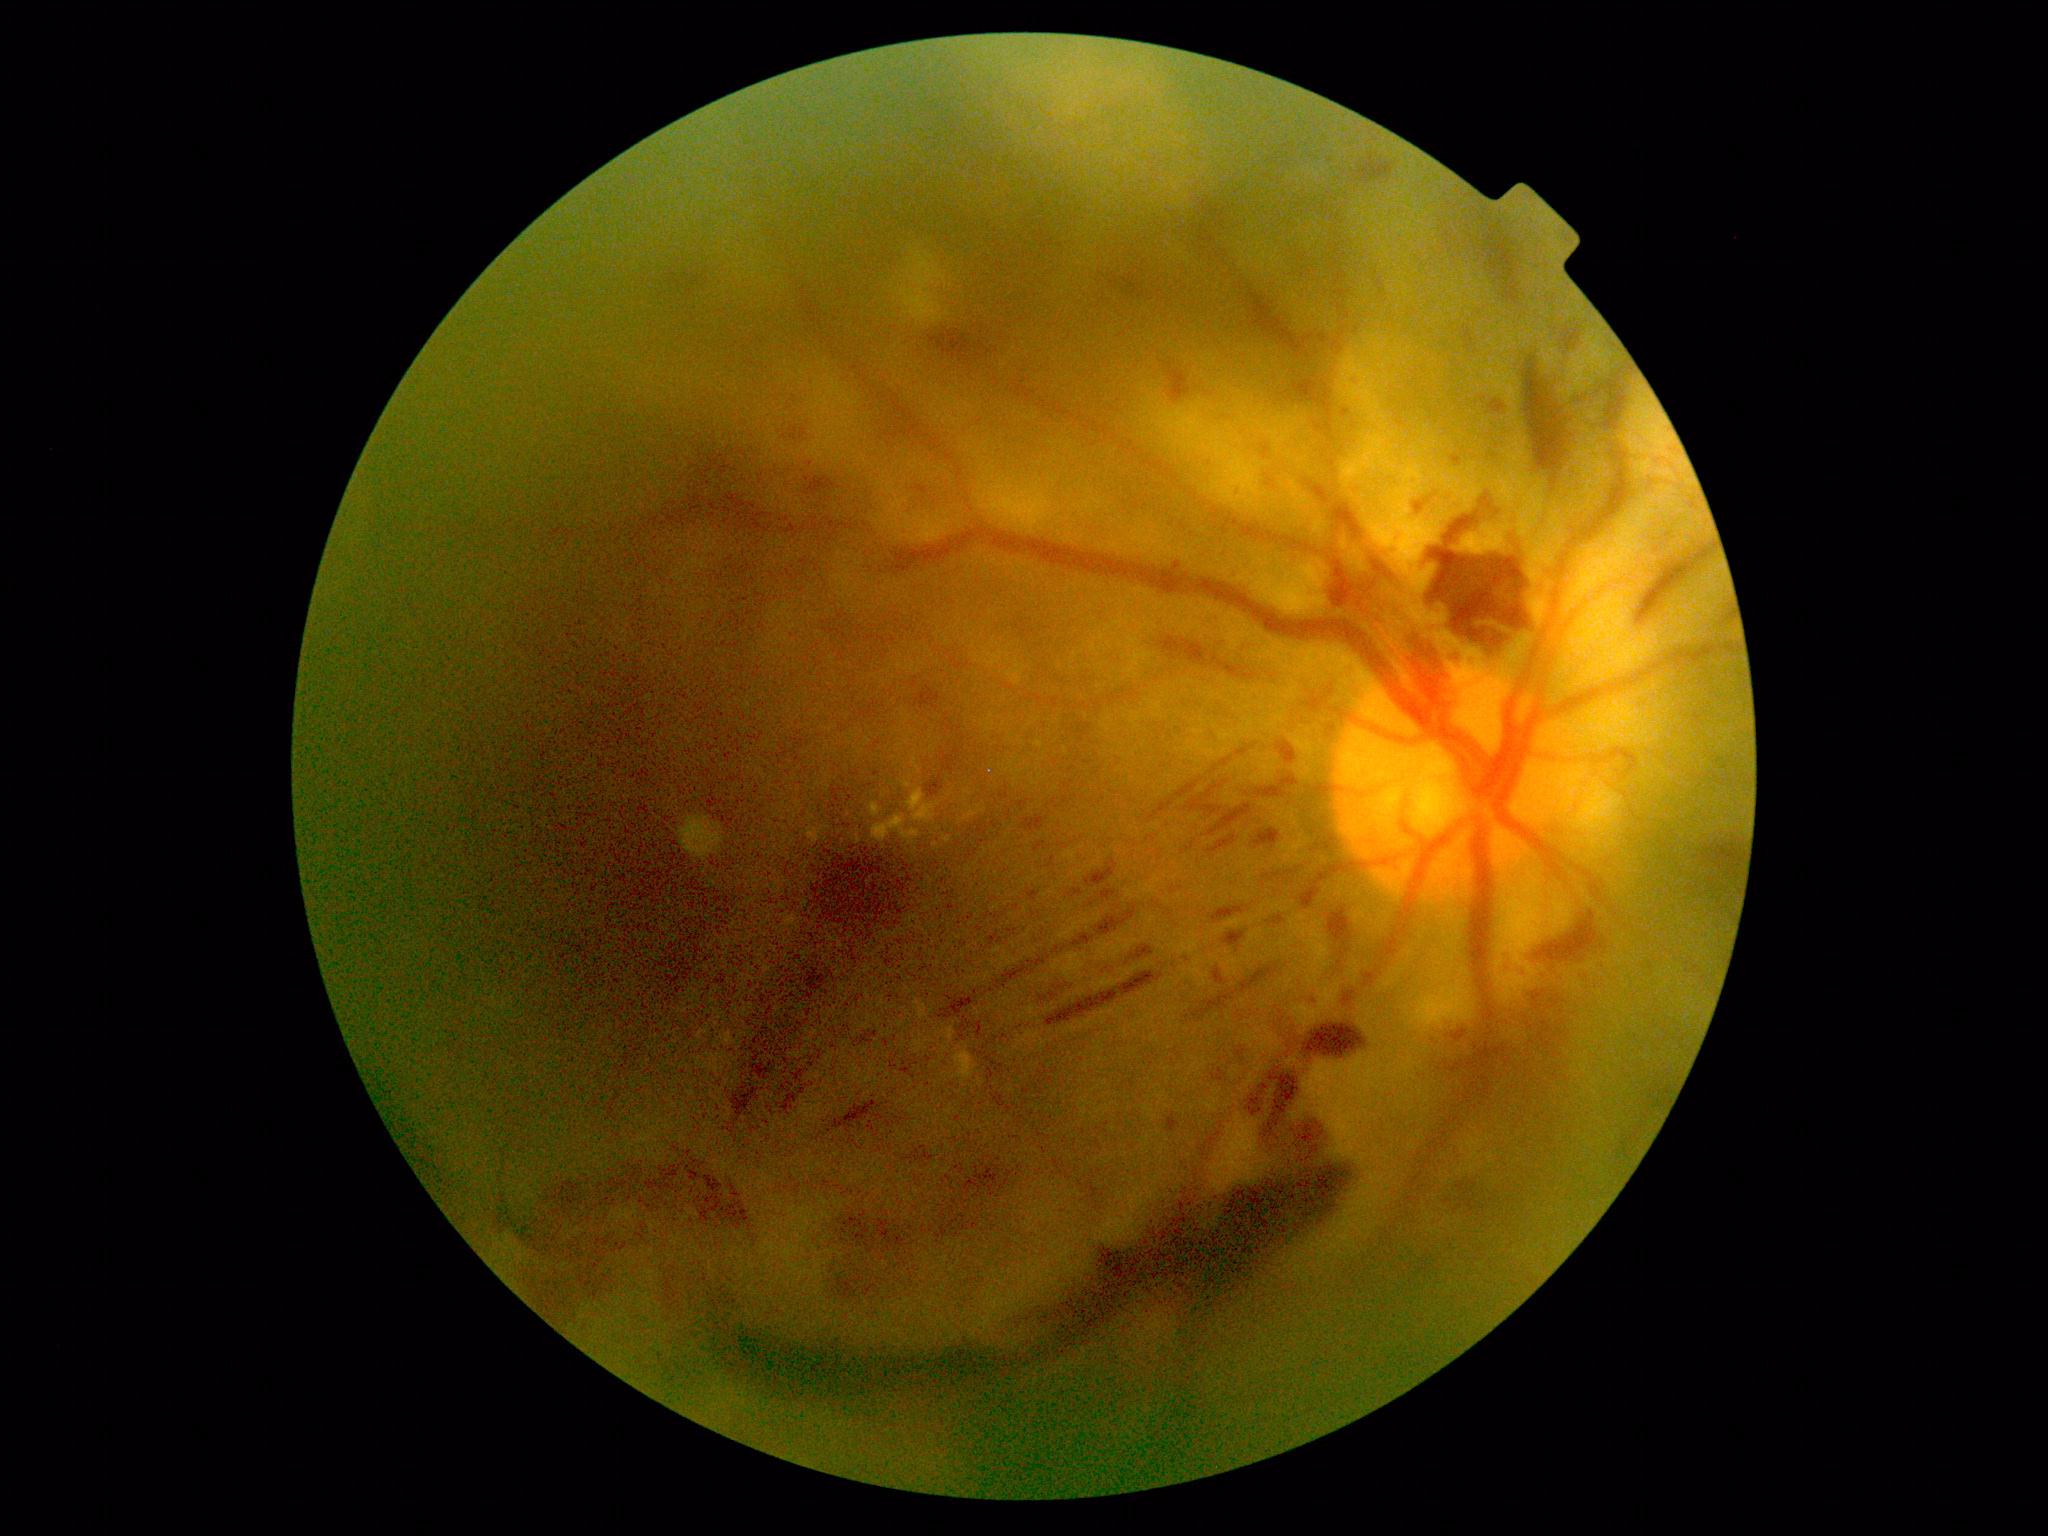
DR stage: 4.